NIDEK AFC-230: 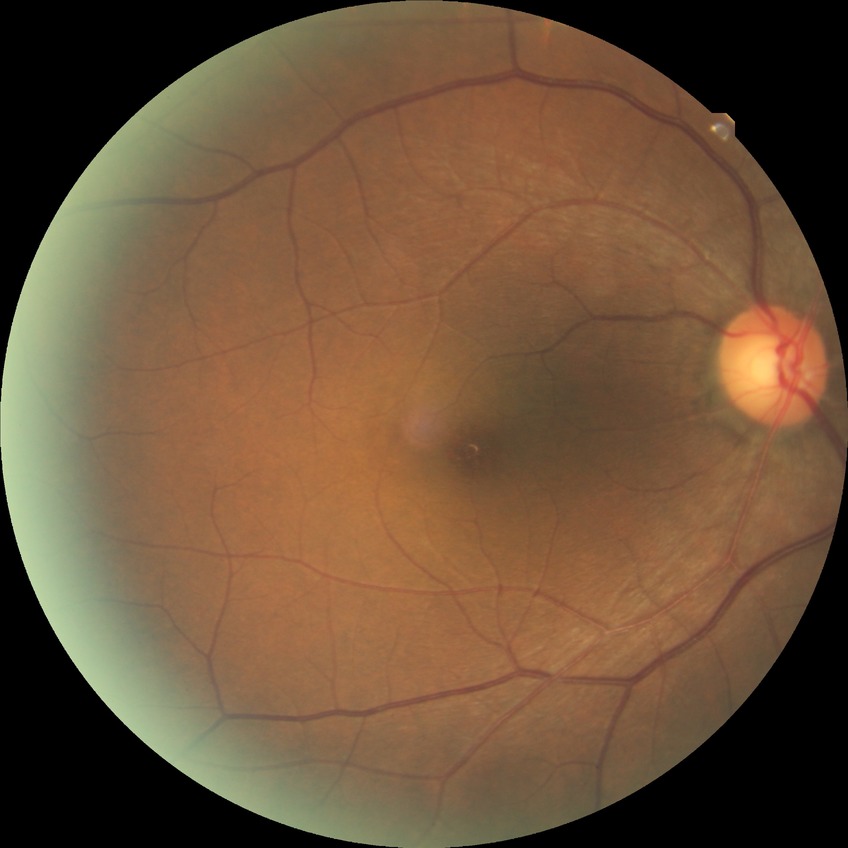
* modified Davis classification — no diabetic retinopathy